Color fundus photograph · nonmydriatic · 45° field of view · NIDEK AFC-230 fundus camera
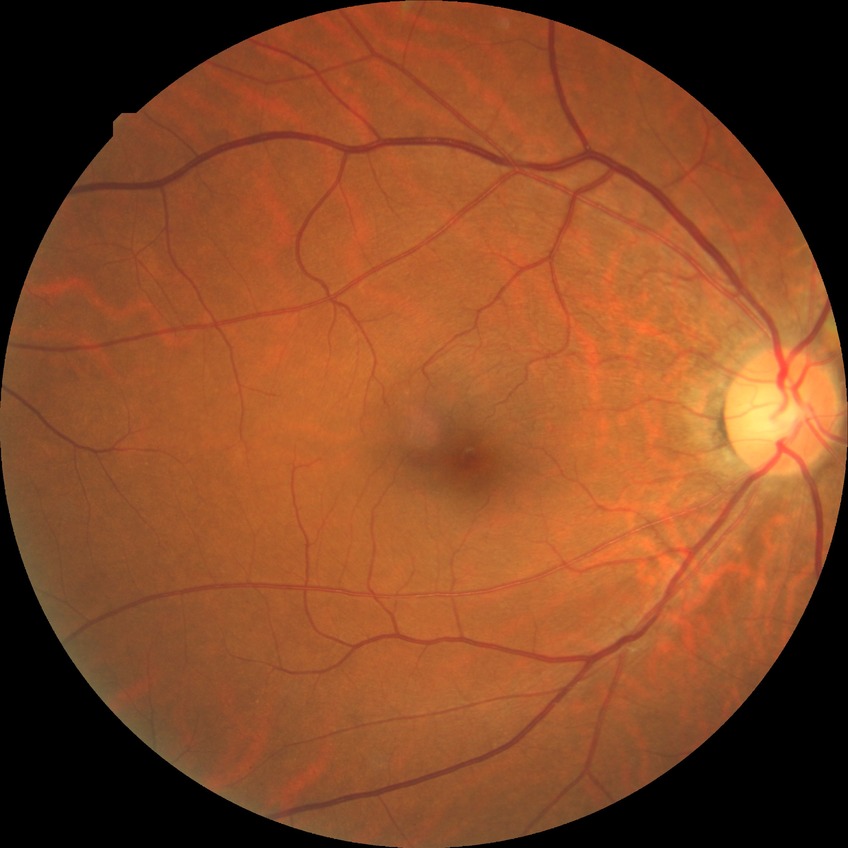
{"davis_grade": "NDR (no diabetic retinopathy)"}